1924 by 1556 pixels · ultra-widefield (UWF) fundus image: 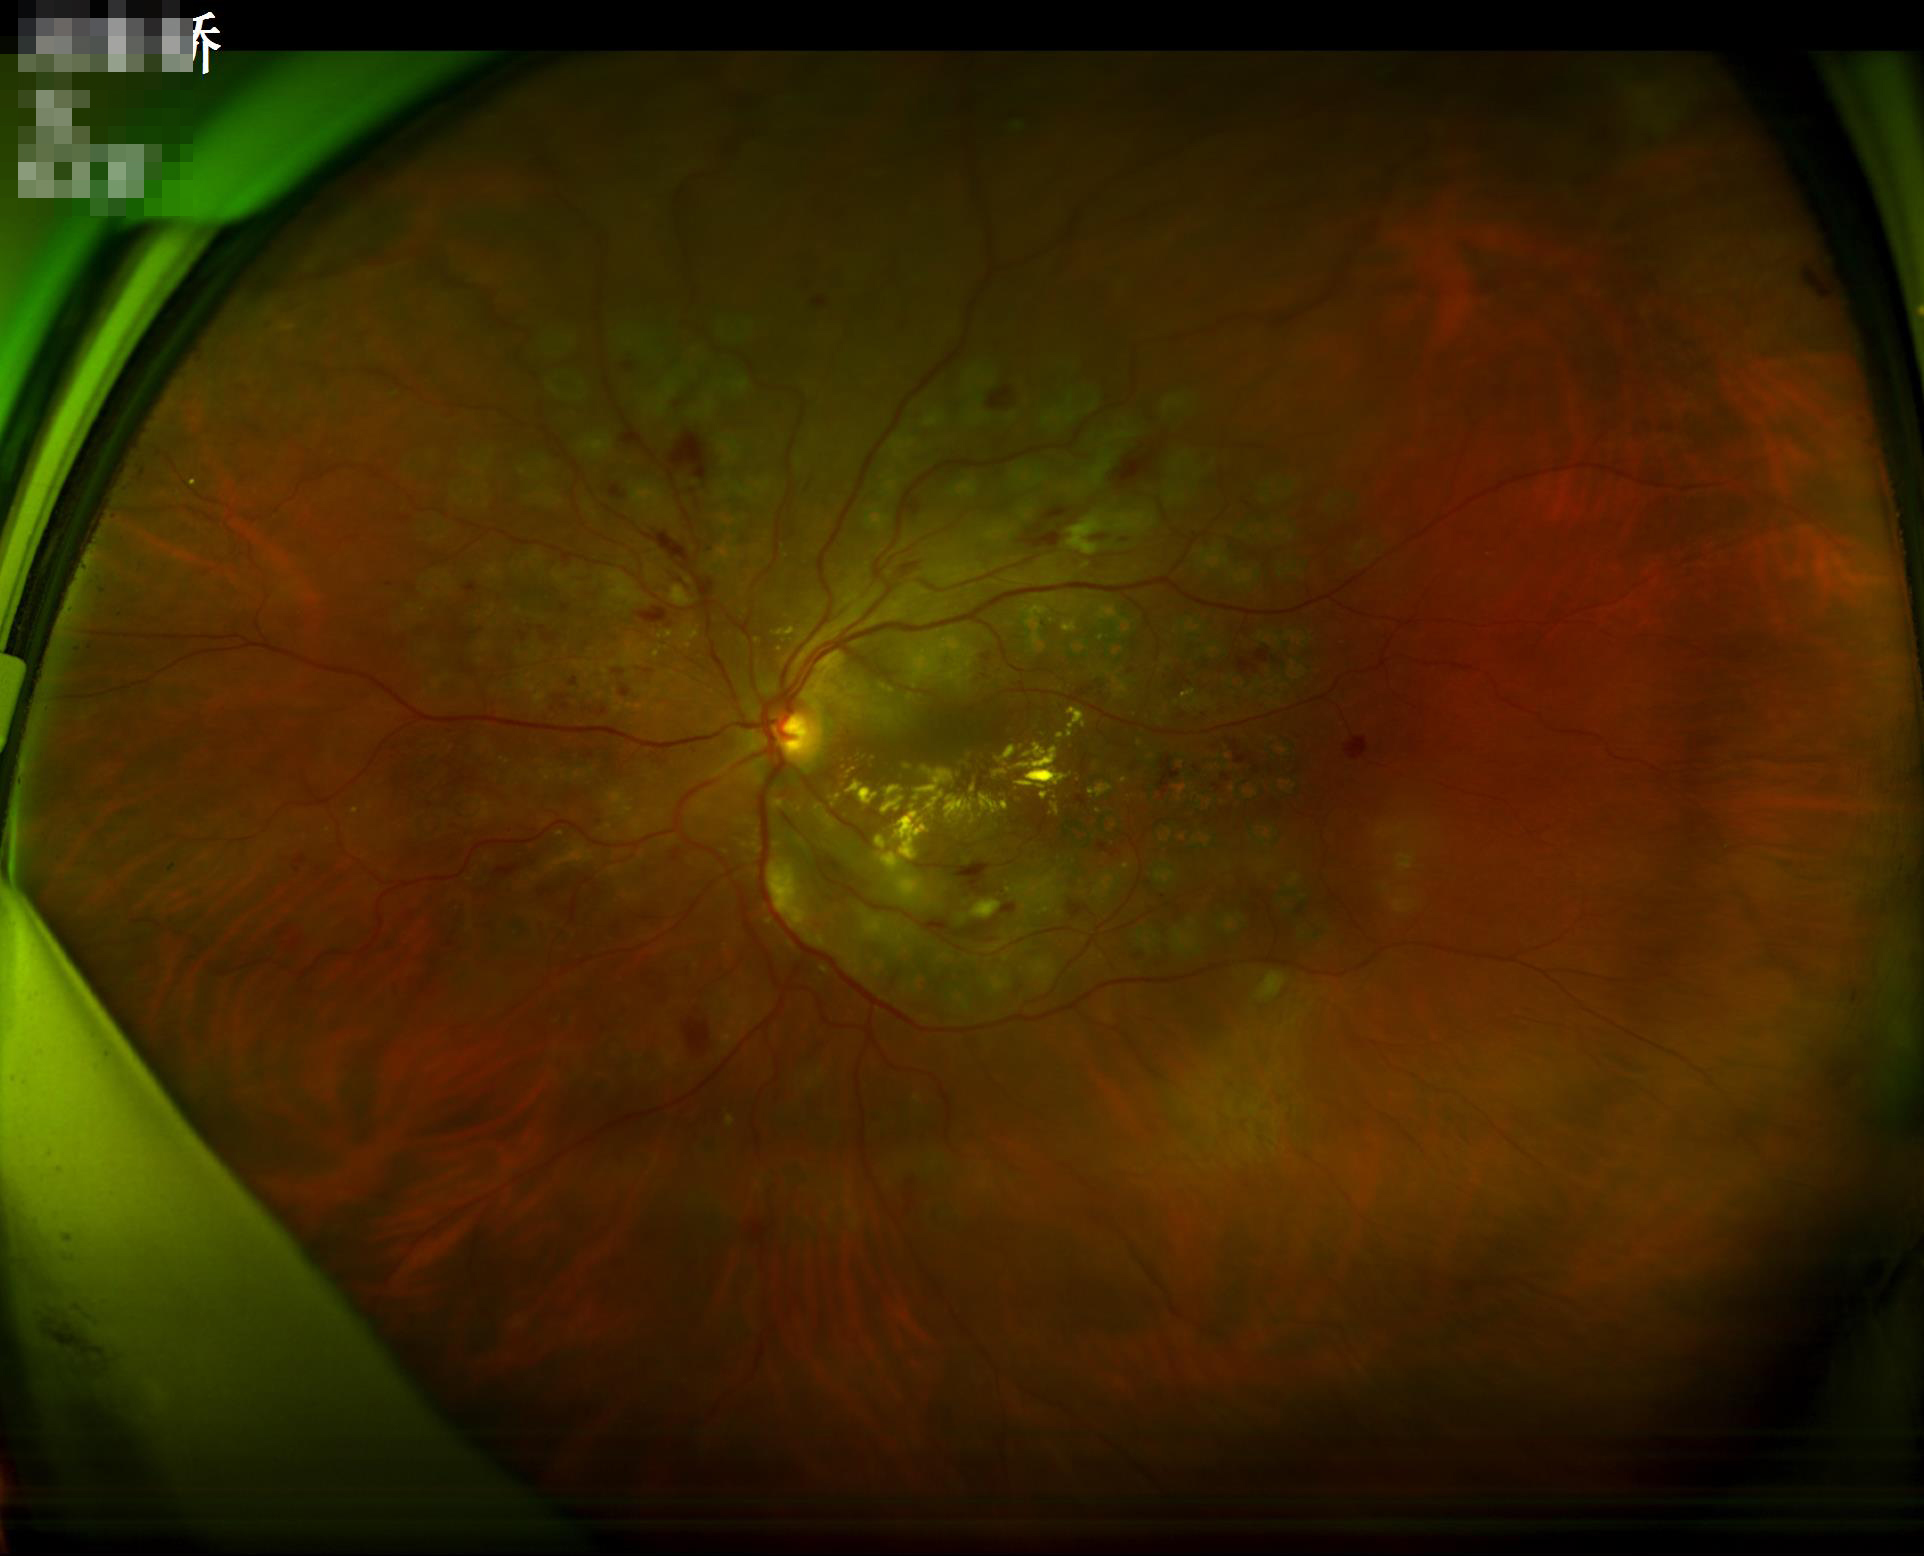

Adequate contrast for distinguishing structures.
The image is clear.